2352 x 1568 pixels.
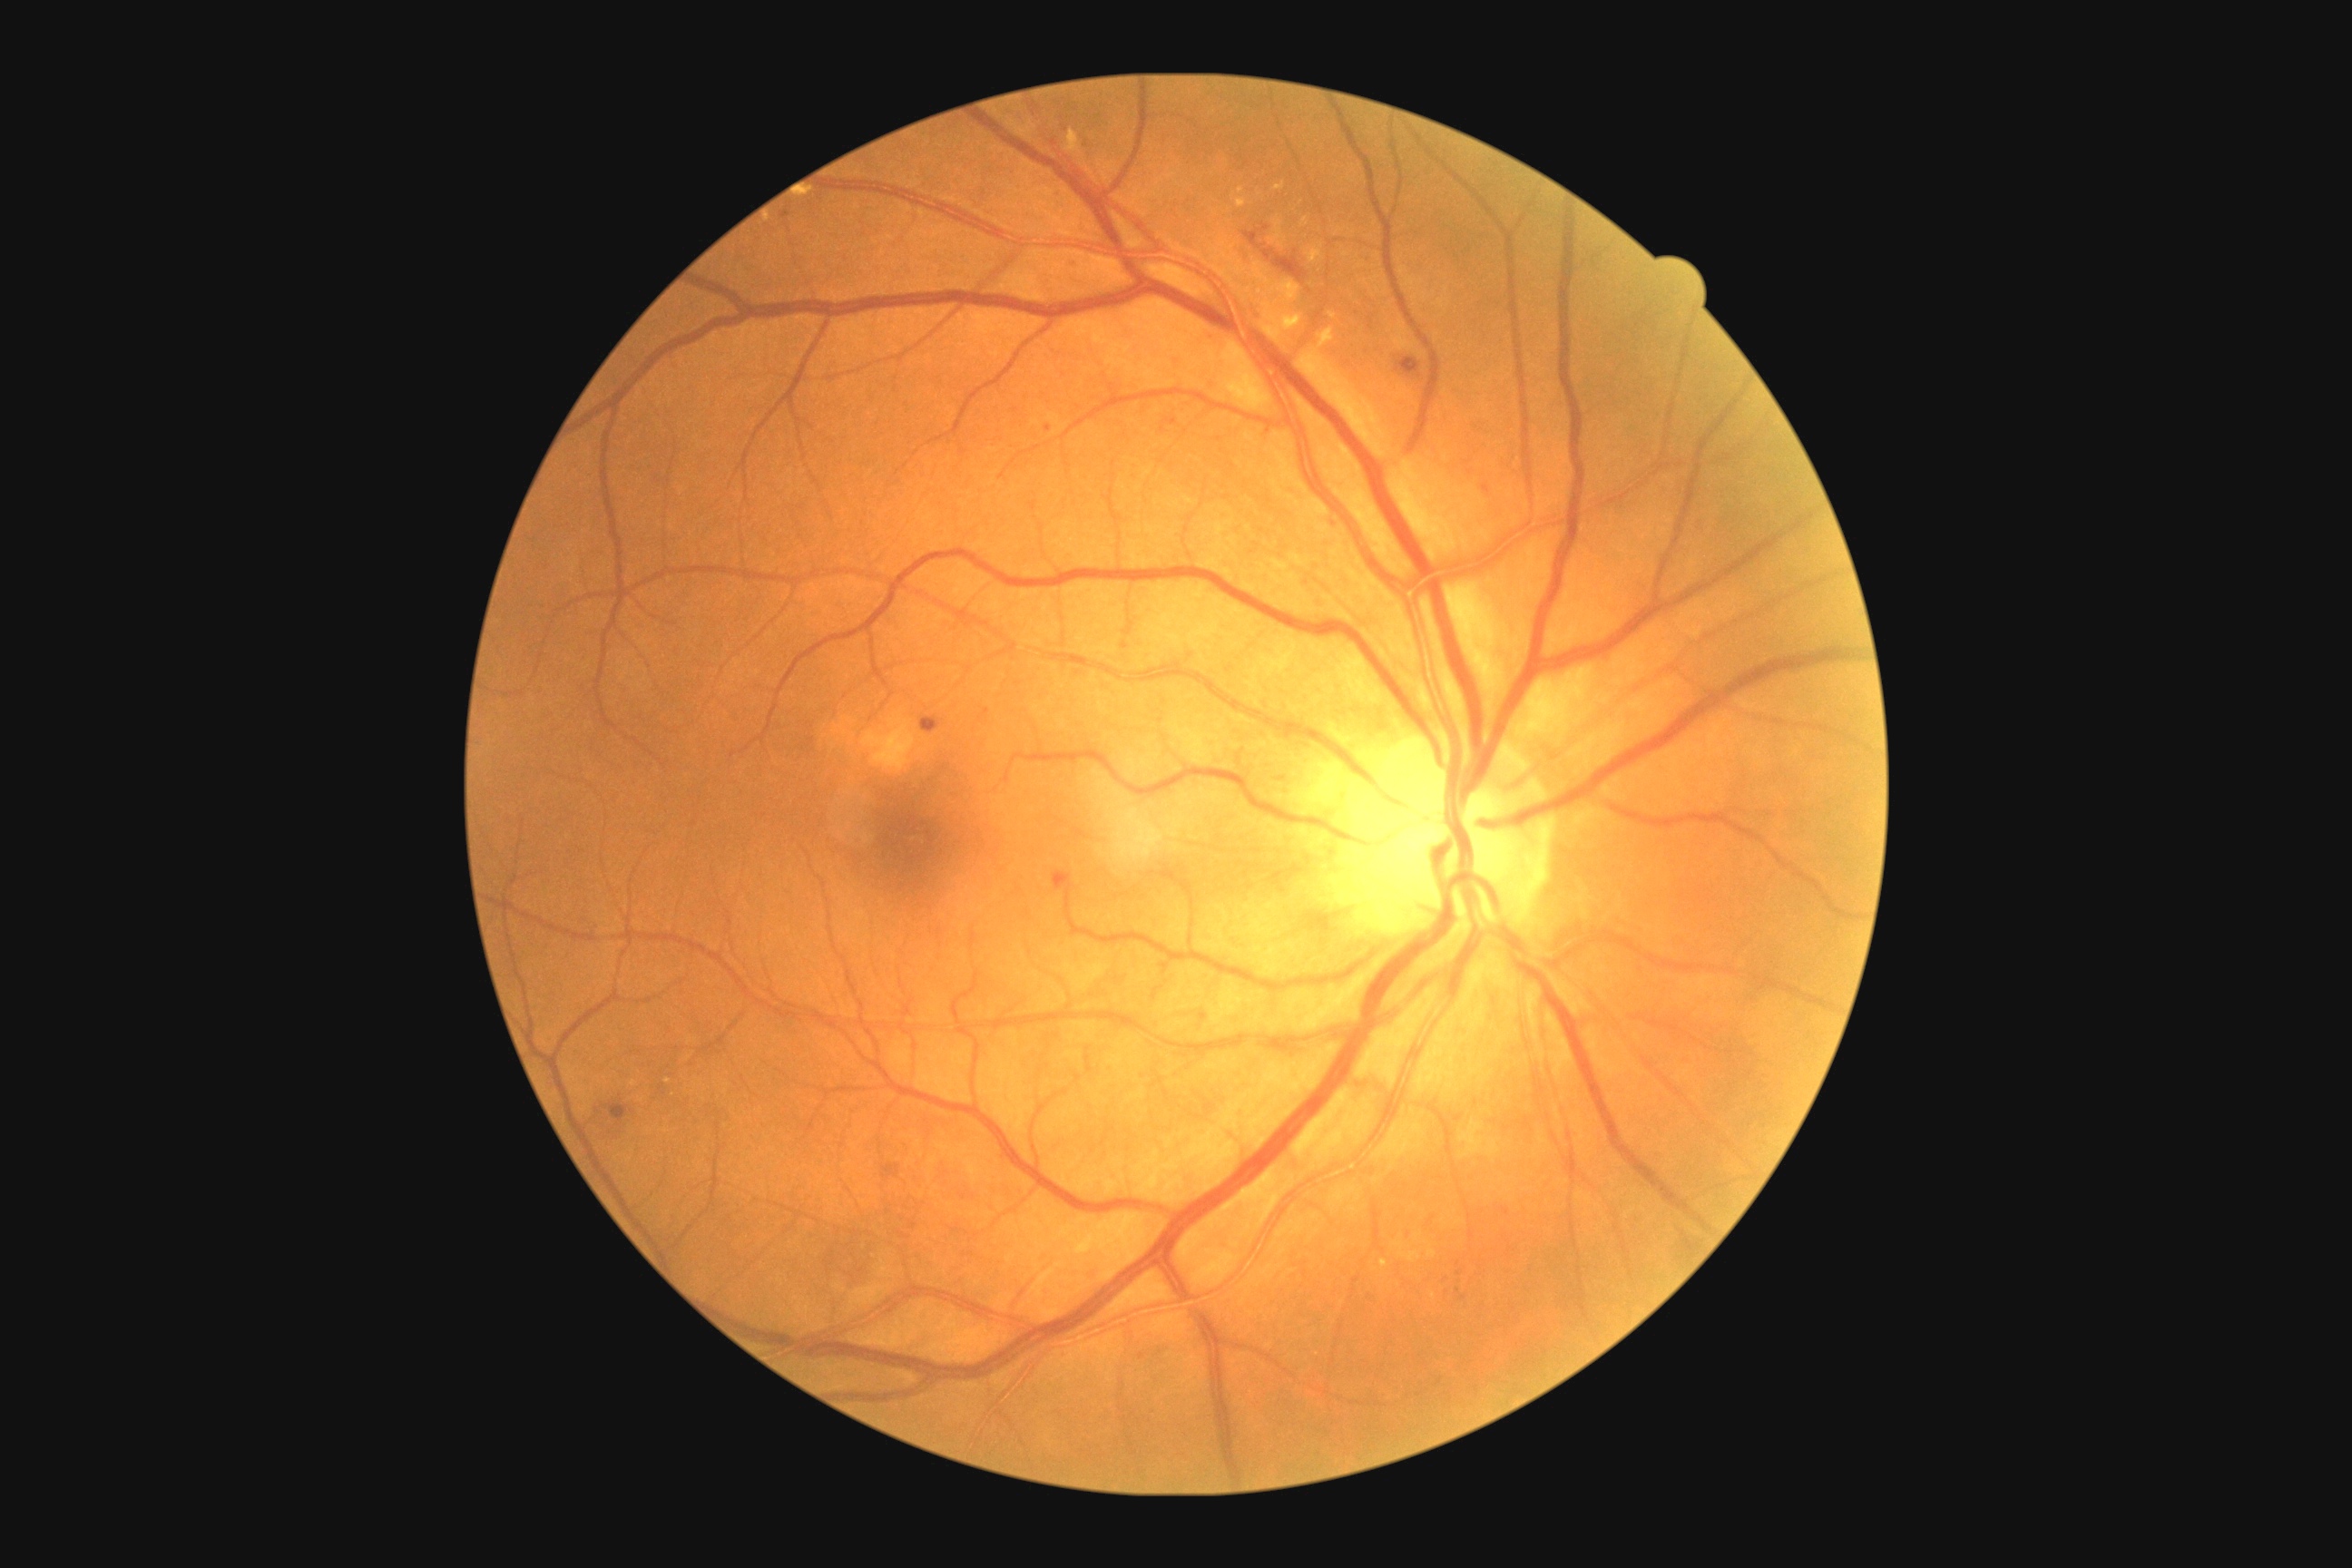

DR severity: grade 2 (moderate NPDR). EXs identified at [x1=1286, y1=315, x2=1302, y2=333], [x1=1329, y1=313, x2=1337, y2=320], [x1=1275, y1=182, x2=1286, y2=190], [x1=1269, y1=280, x2=1302, y2=304], [x1=1237, y1=199, x2=1248, y2=208], [x1=798, y1=191, x2=816, y2=204], [x1=1380, y1=1260, x2=1387, y2=1268], [x1=1318, y1=328, x2=1335, y2=346], [x1=1308, y1=248, x2=1322, y2=262], [x1=1066, y1=130, x2=1081, y2=155]. Small EXs approximately at (1241; 190), (1346; 255), (1340; 231), (1305; 222), (634; 1084), (668; 1081). No SEs identified. MAs identified at [x1=779, y1=211, x2=790, y2=219], [x1=1070, y1=259, x2=1083, y2=271], [x1=1502, y1=1208, x2=1511, y2=1215], [x1=1044, y1=426, x2=1054, y2=433], [x1=1482, y1=484, x2=1491, y2=495], [x1=1166, y1=418, x2=1177, y2=426], [x1=1054, y1=193, x2=1059, y2=202], [x1=1266, y1=427, x2=1271, y2=435]. Small MAs approximately at (1016; 411), (1162; 431), (1608; 660), (1406; 1236), (963; 452), (1335; 523), (1143; 1356), (987; 712), (1213; 336). HEs identified at [x1=1396, y1=358, x2=1422, y2=378], [x1=883, y1=1164, x2=899, y2=1179], [x1=609, y1=1104, x2=629, y2=1124], [x1=1054, y1=872, x2=1073, y2=890], [x1=921, y1=718, x2=943, y2=734], [x1=1246, y1=222, x2=1306, y2=280].